1924 x 1556 pixels, wide-field retinal mosaic image:
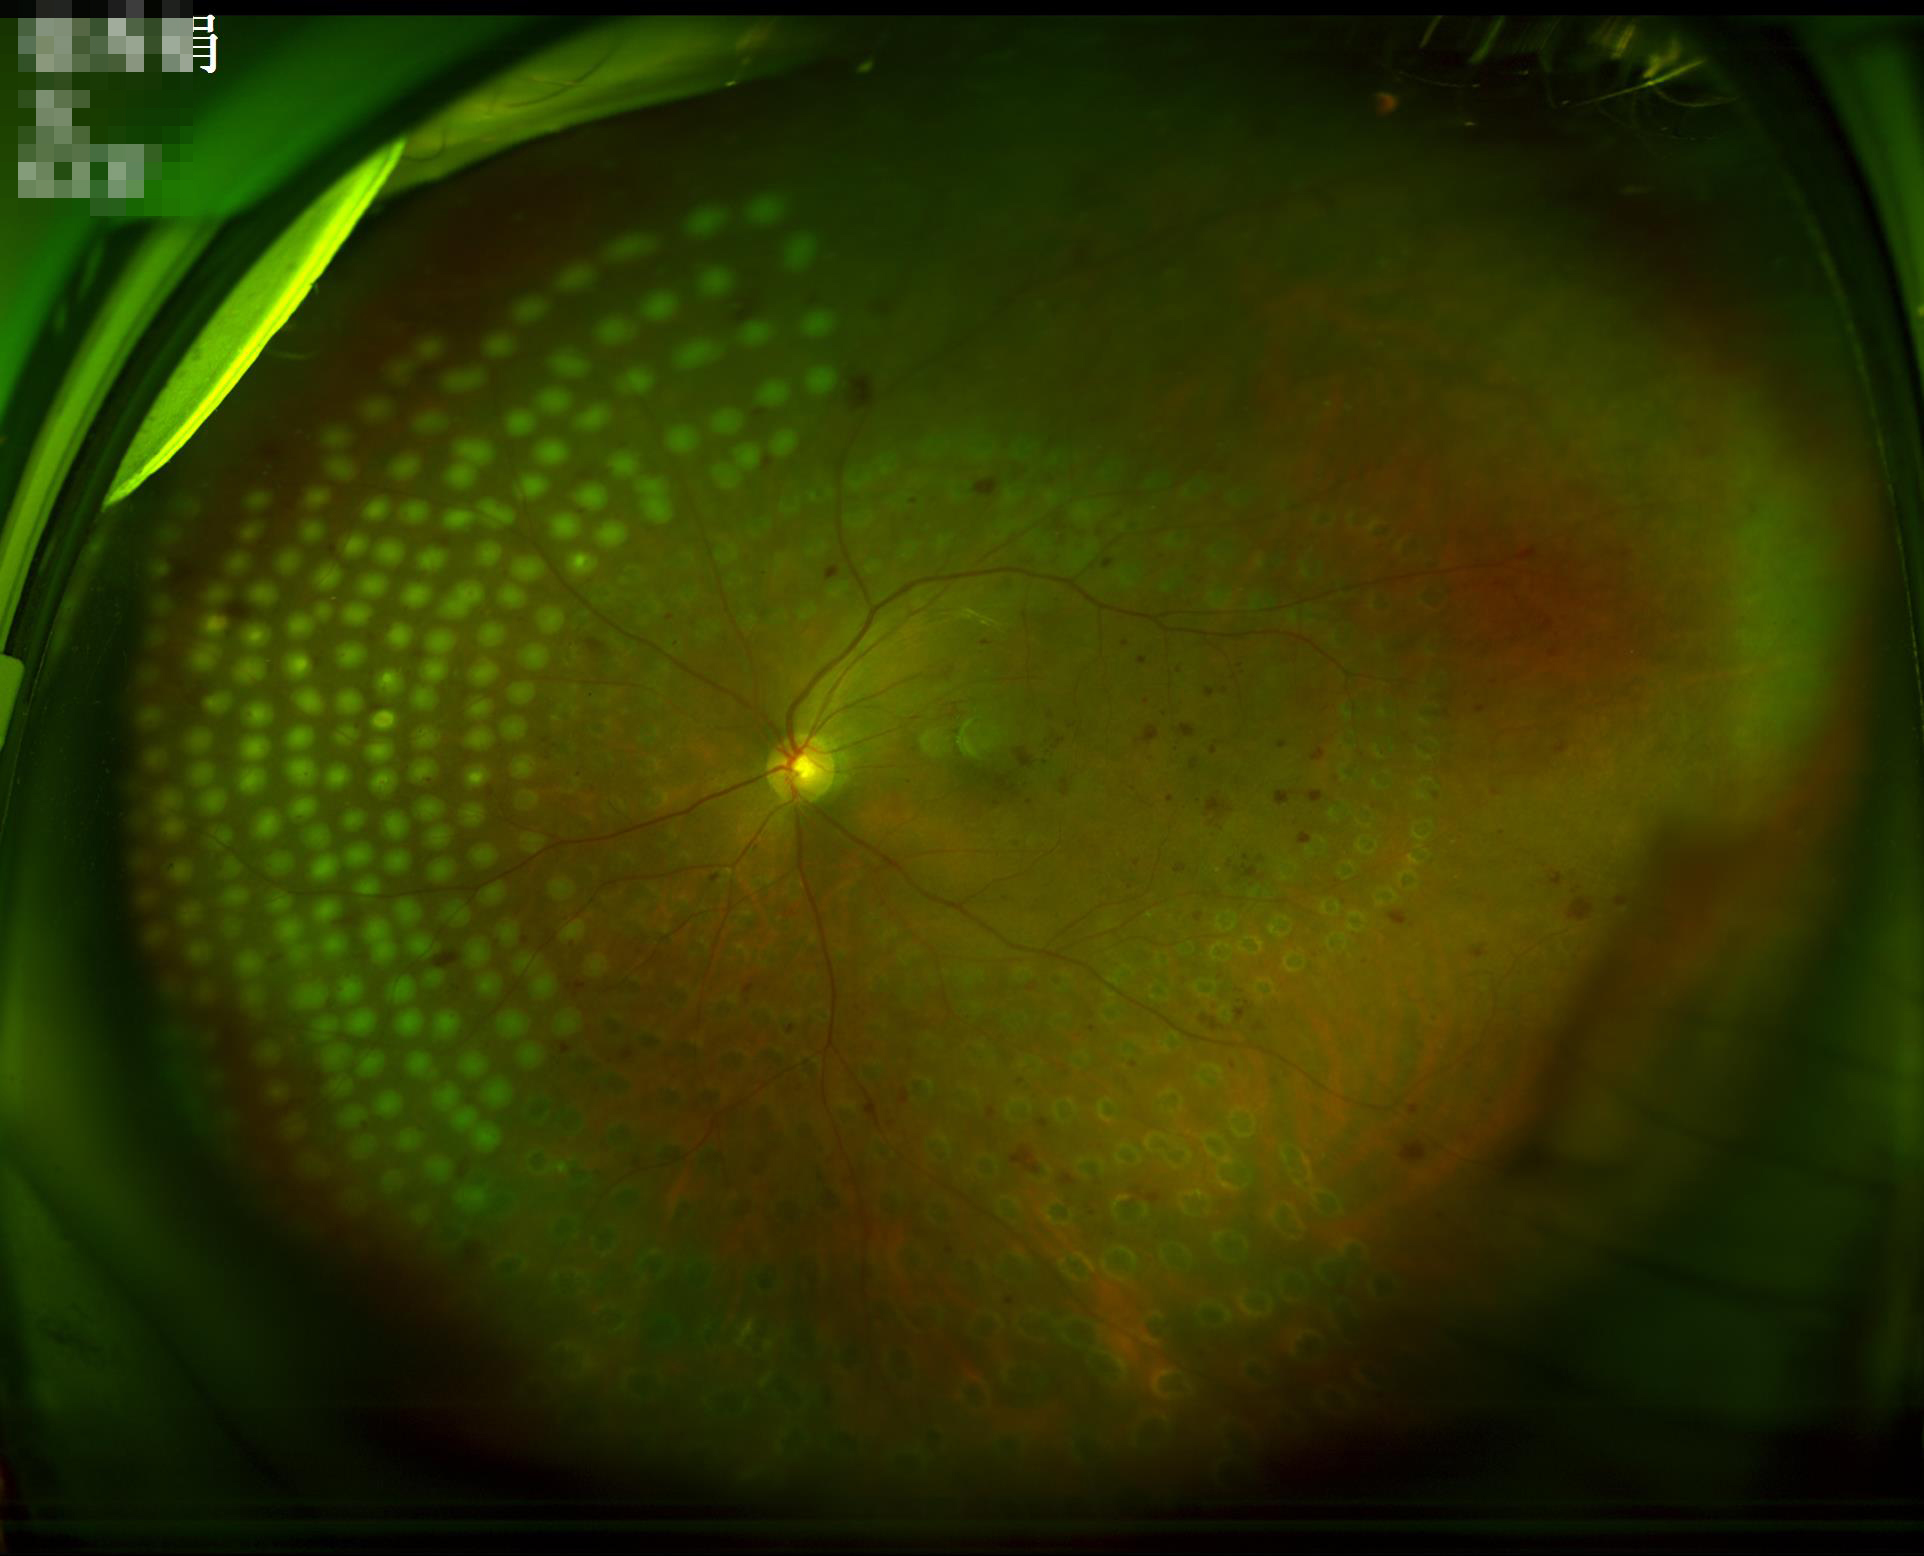
Image quality assessment: contrast: satisfactory | overall: adequate | clarity: good | illumination: adequate.